Wide-field fundus photograph of an infant: 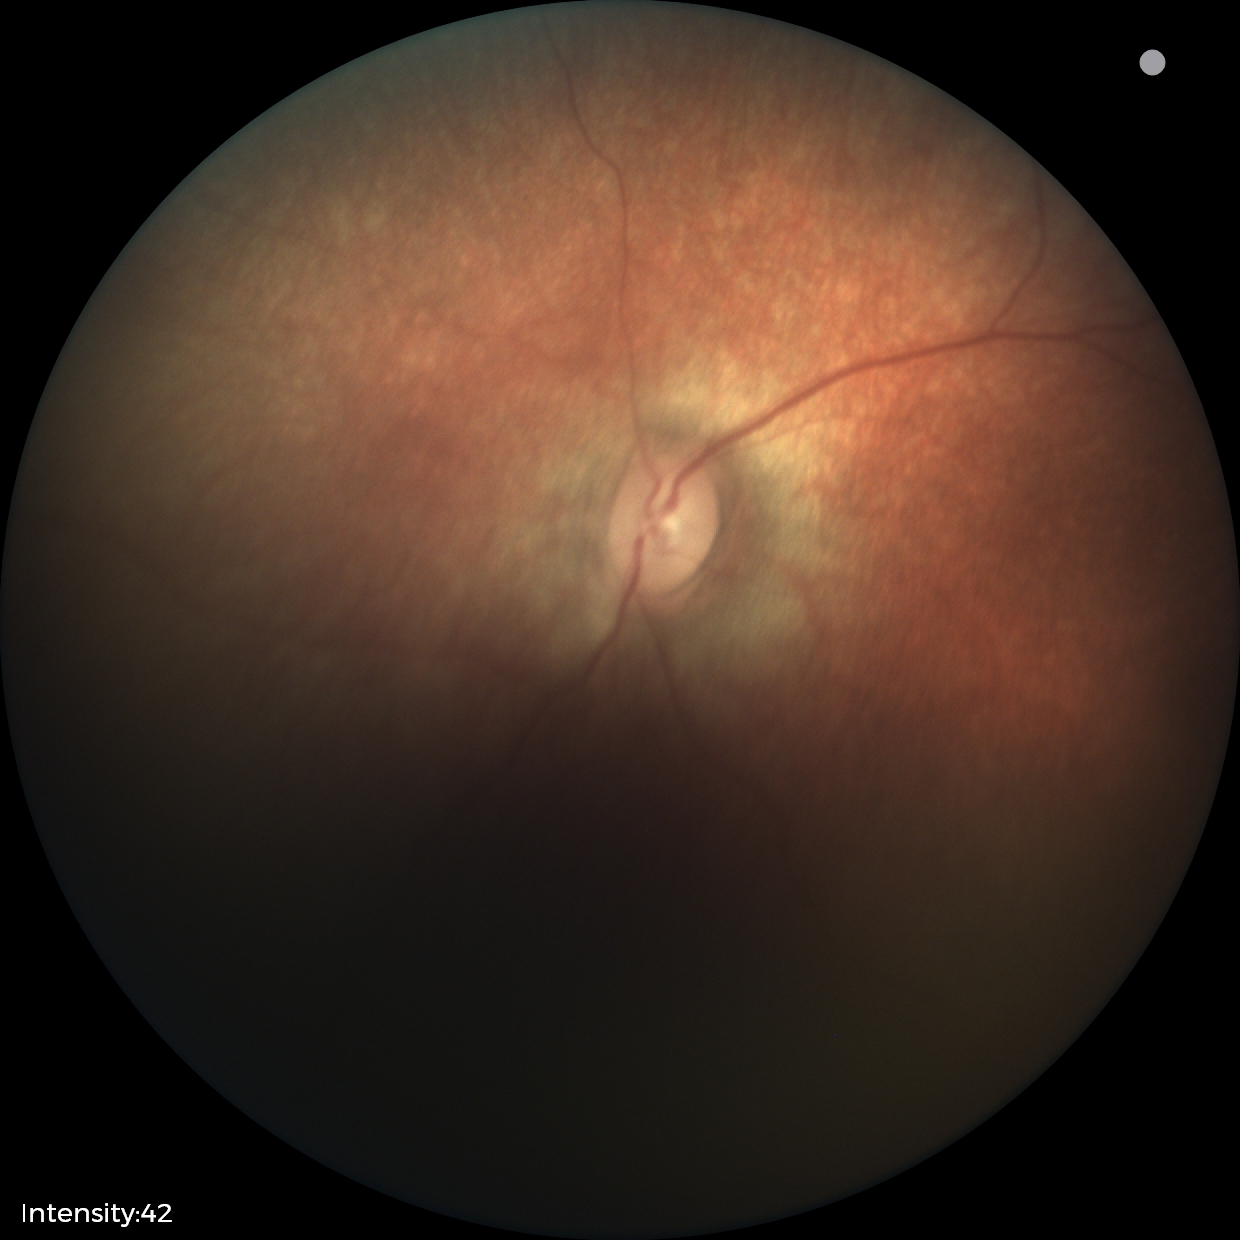
Screening examination diagnosed as physiological.